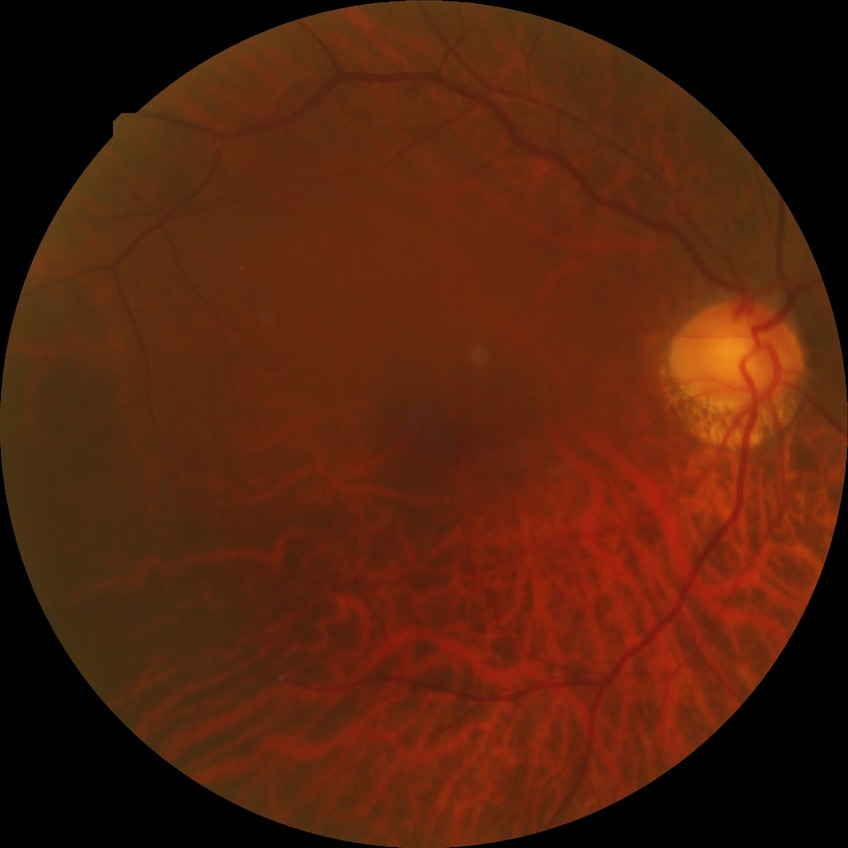 Davis grade is NDR.